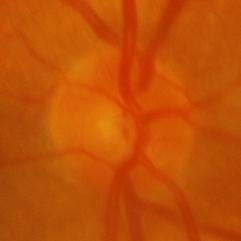

Showing glaucoma.